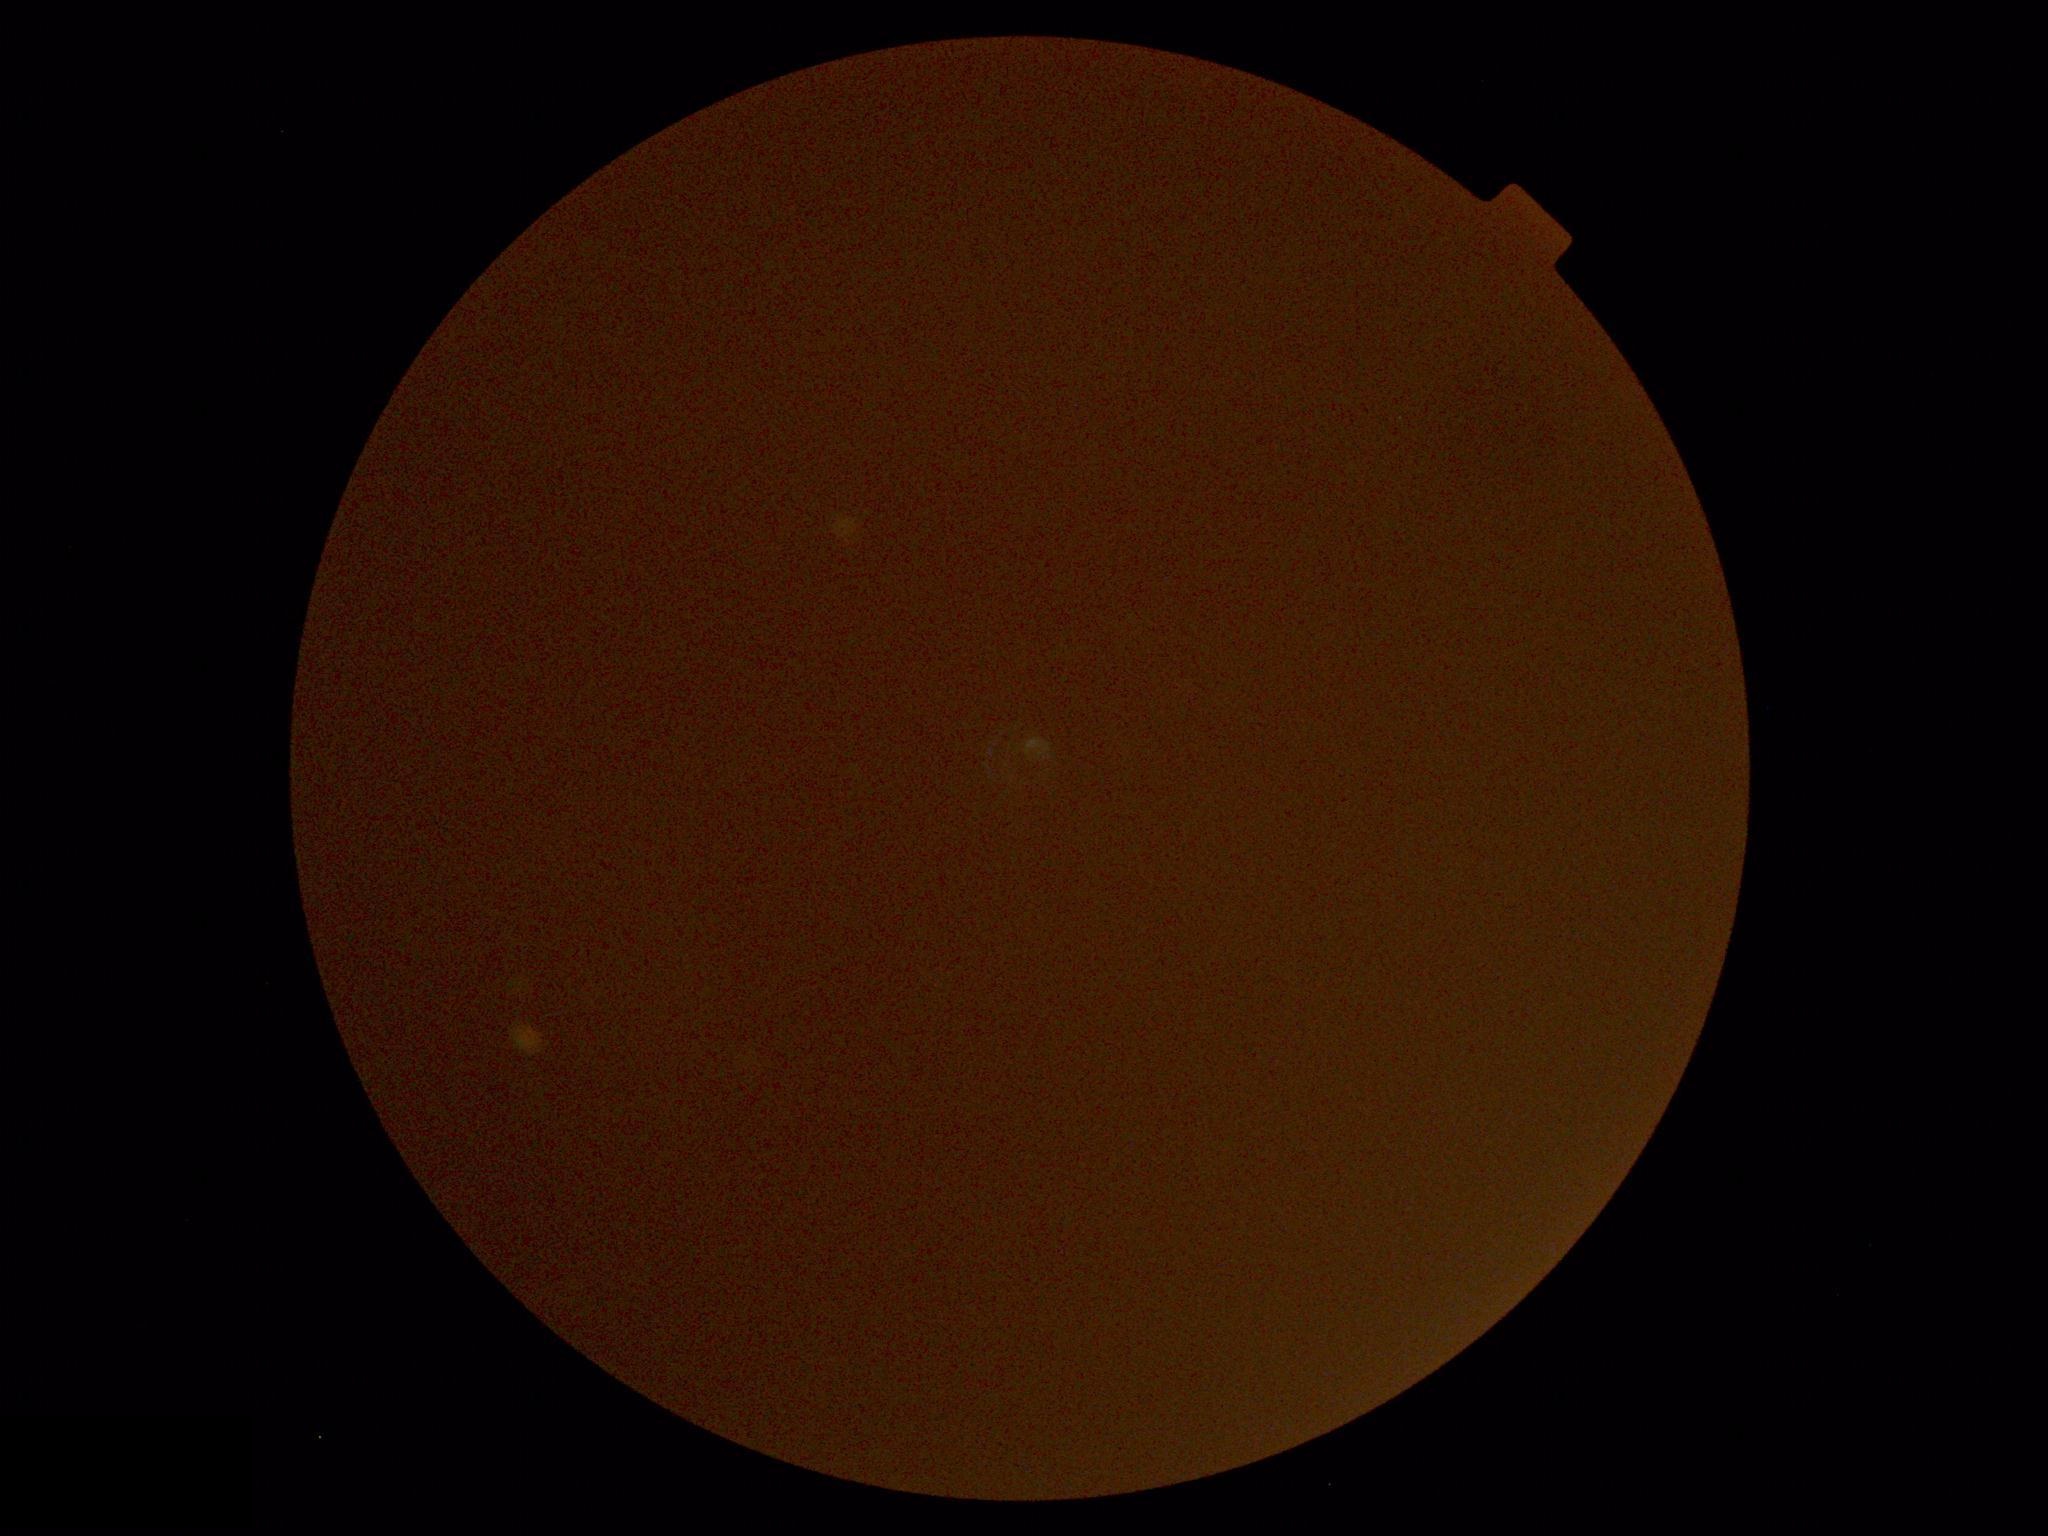
DR stage is ungradable. Quality too poor to assess for DR.